Nonmydriatic fundus photograph; 45° field of view; camera: NIDEK AFC-230 — 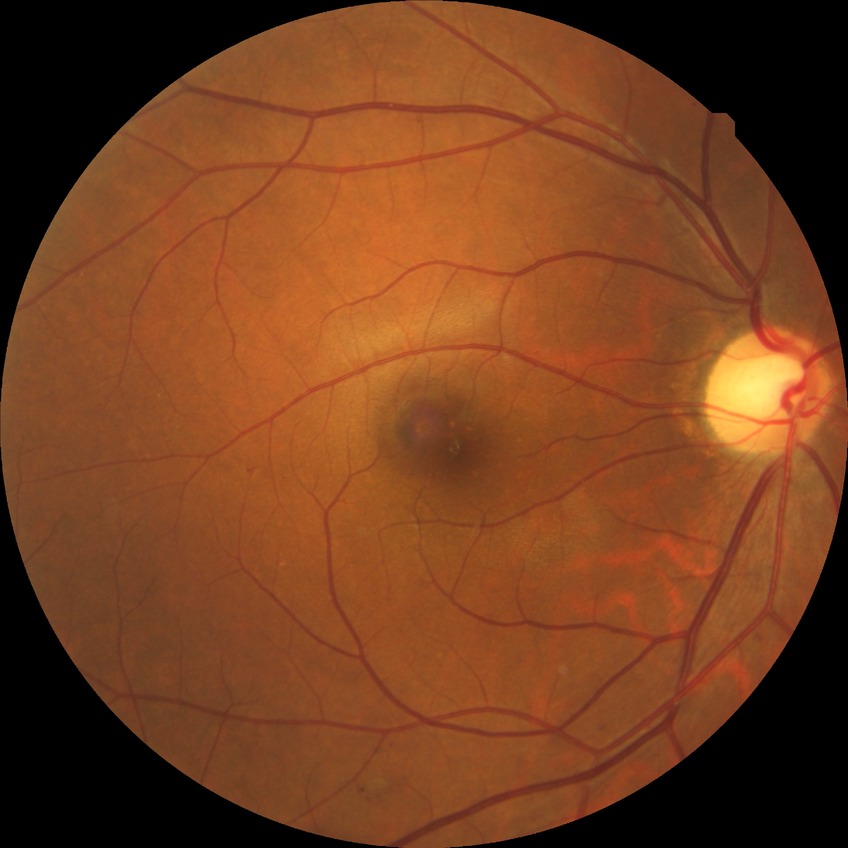
Retinopathy grade: no diabetic retinopathy.